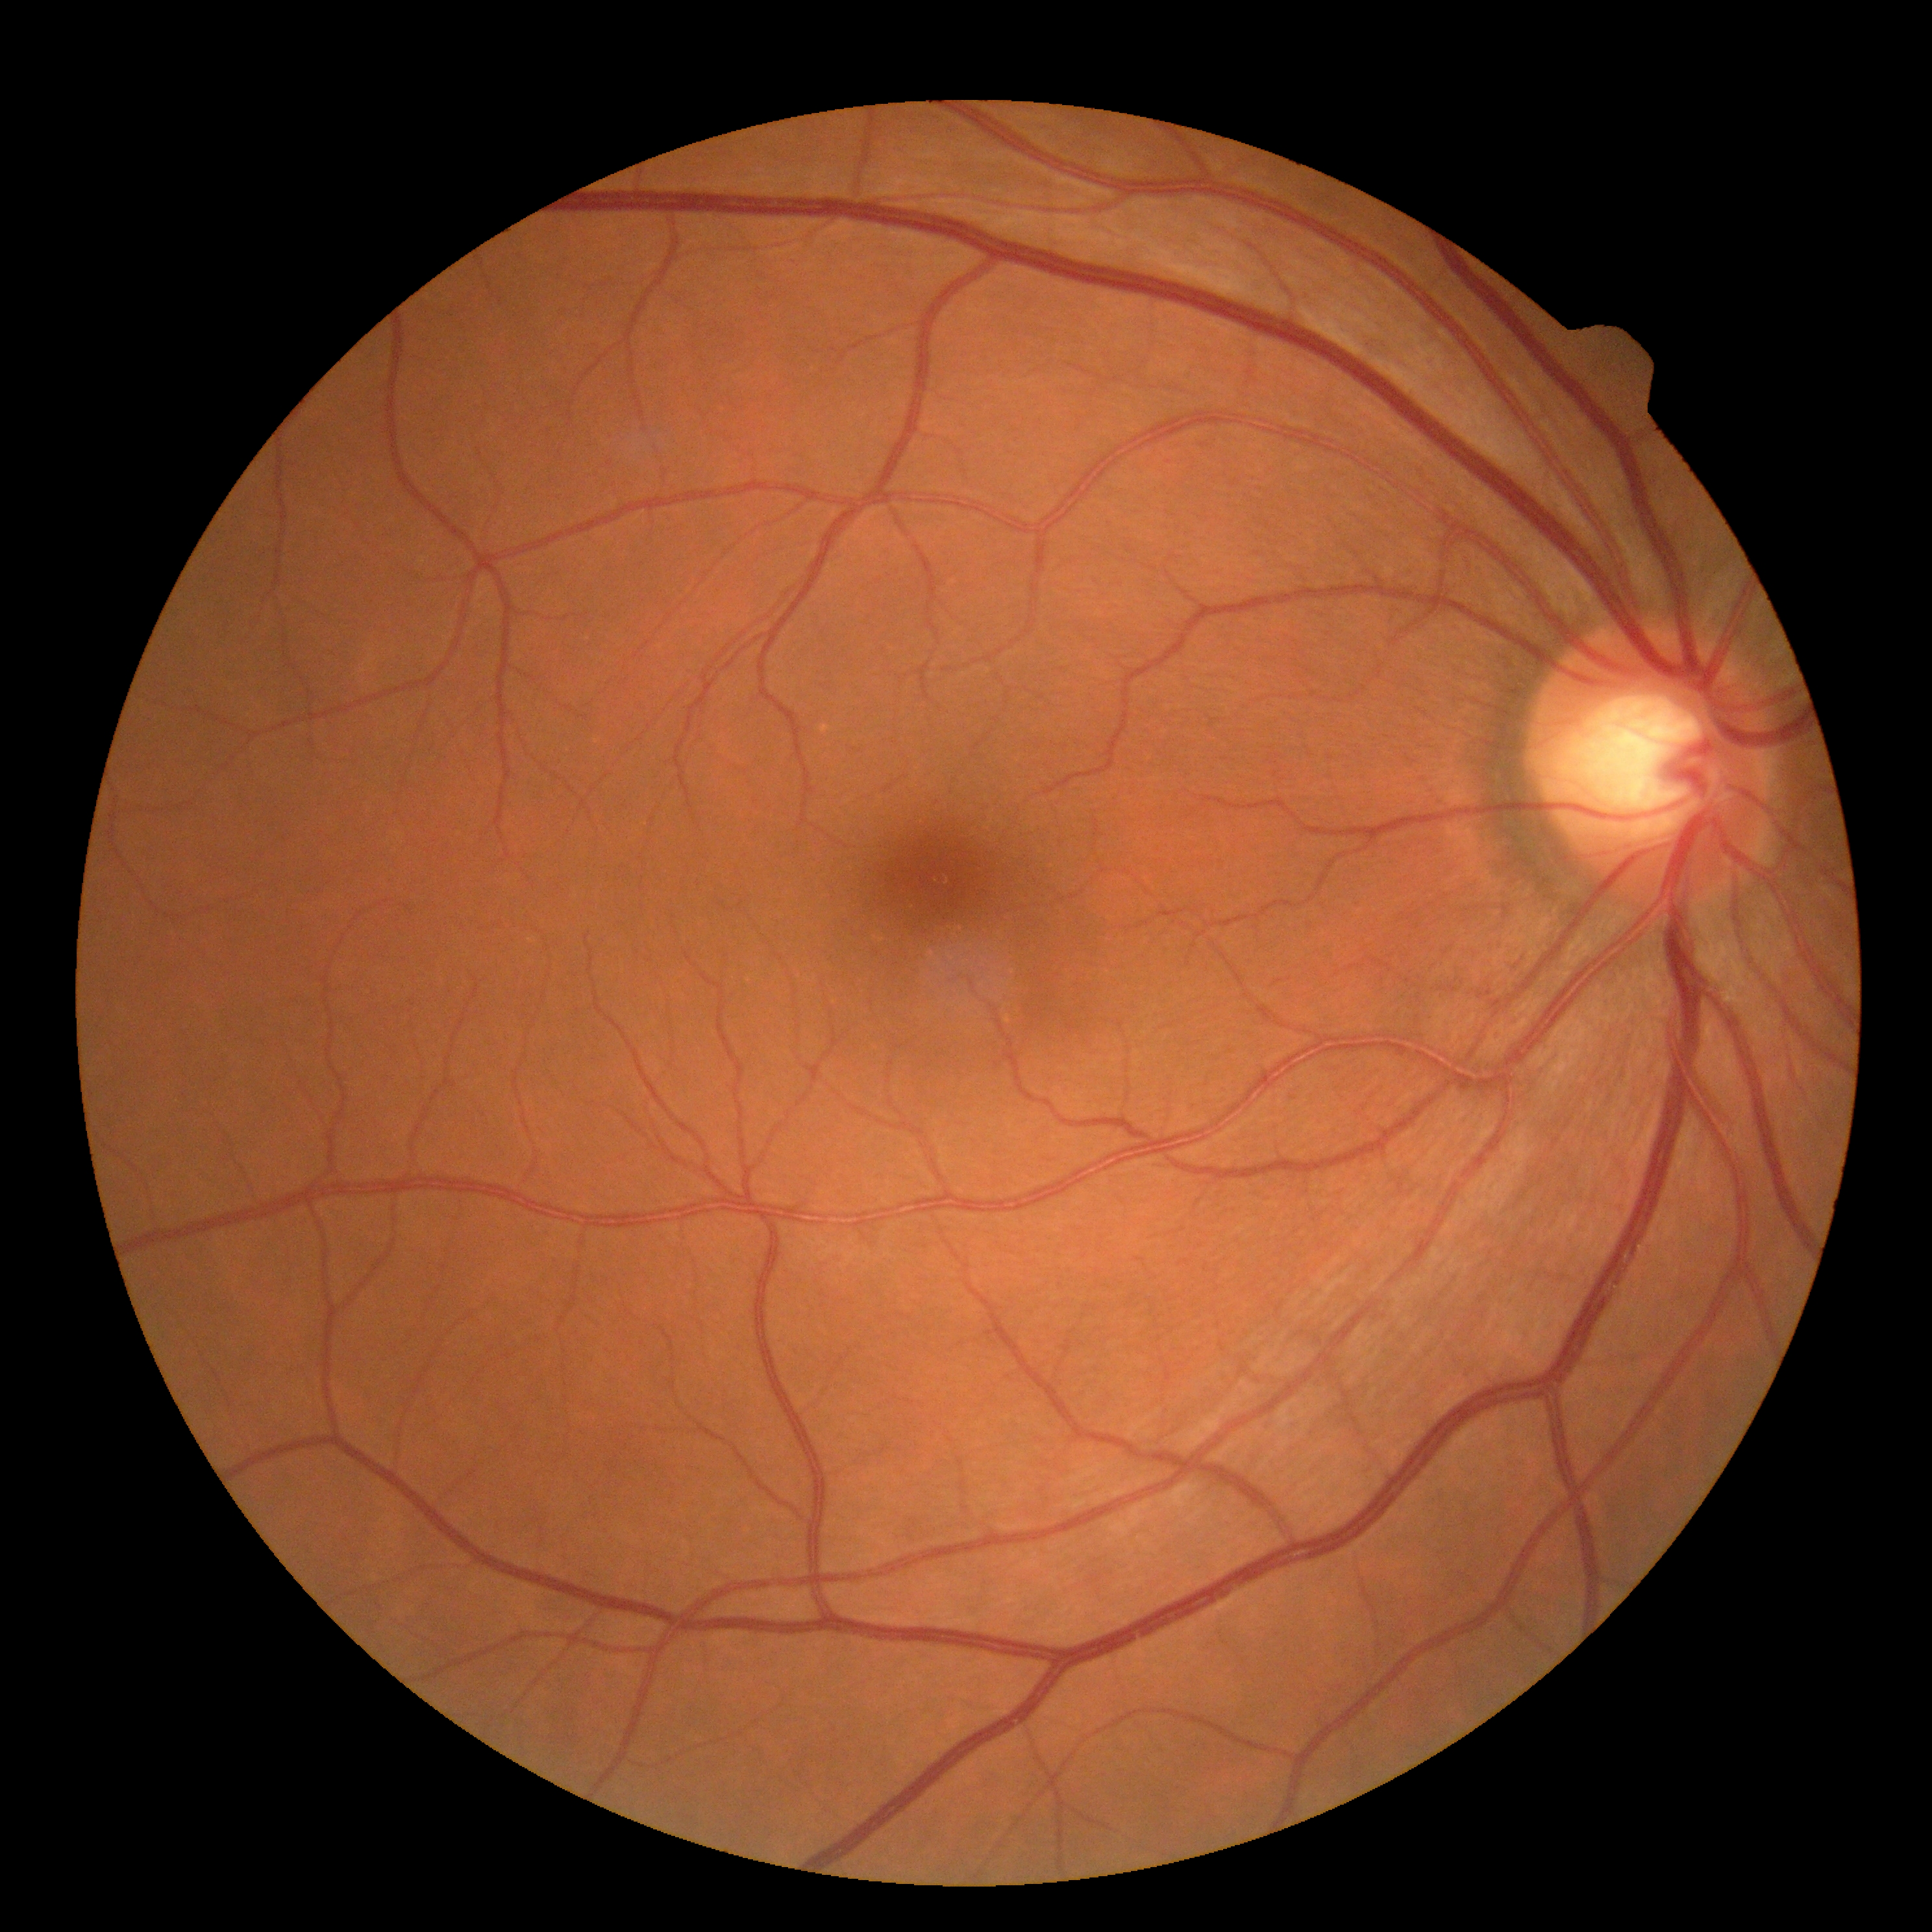
DR grade: 0/4.